412 by 310 pixels — 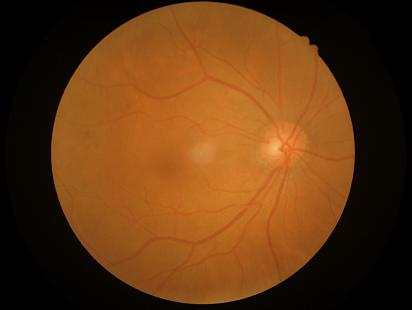
Overall quality is good and the image is gradable.
Image is sharp throughout the field.
Adequate contrast for distinguishing structures.